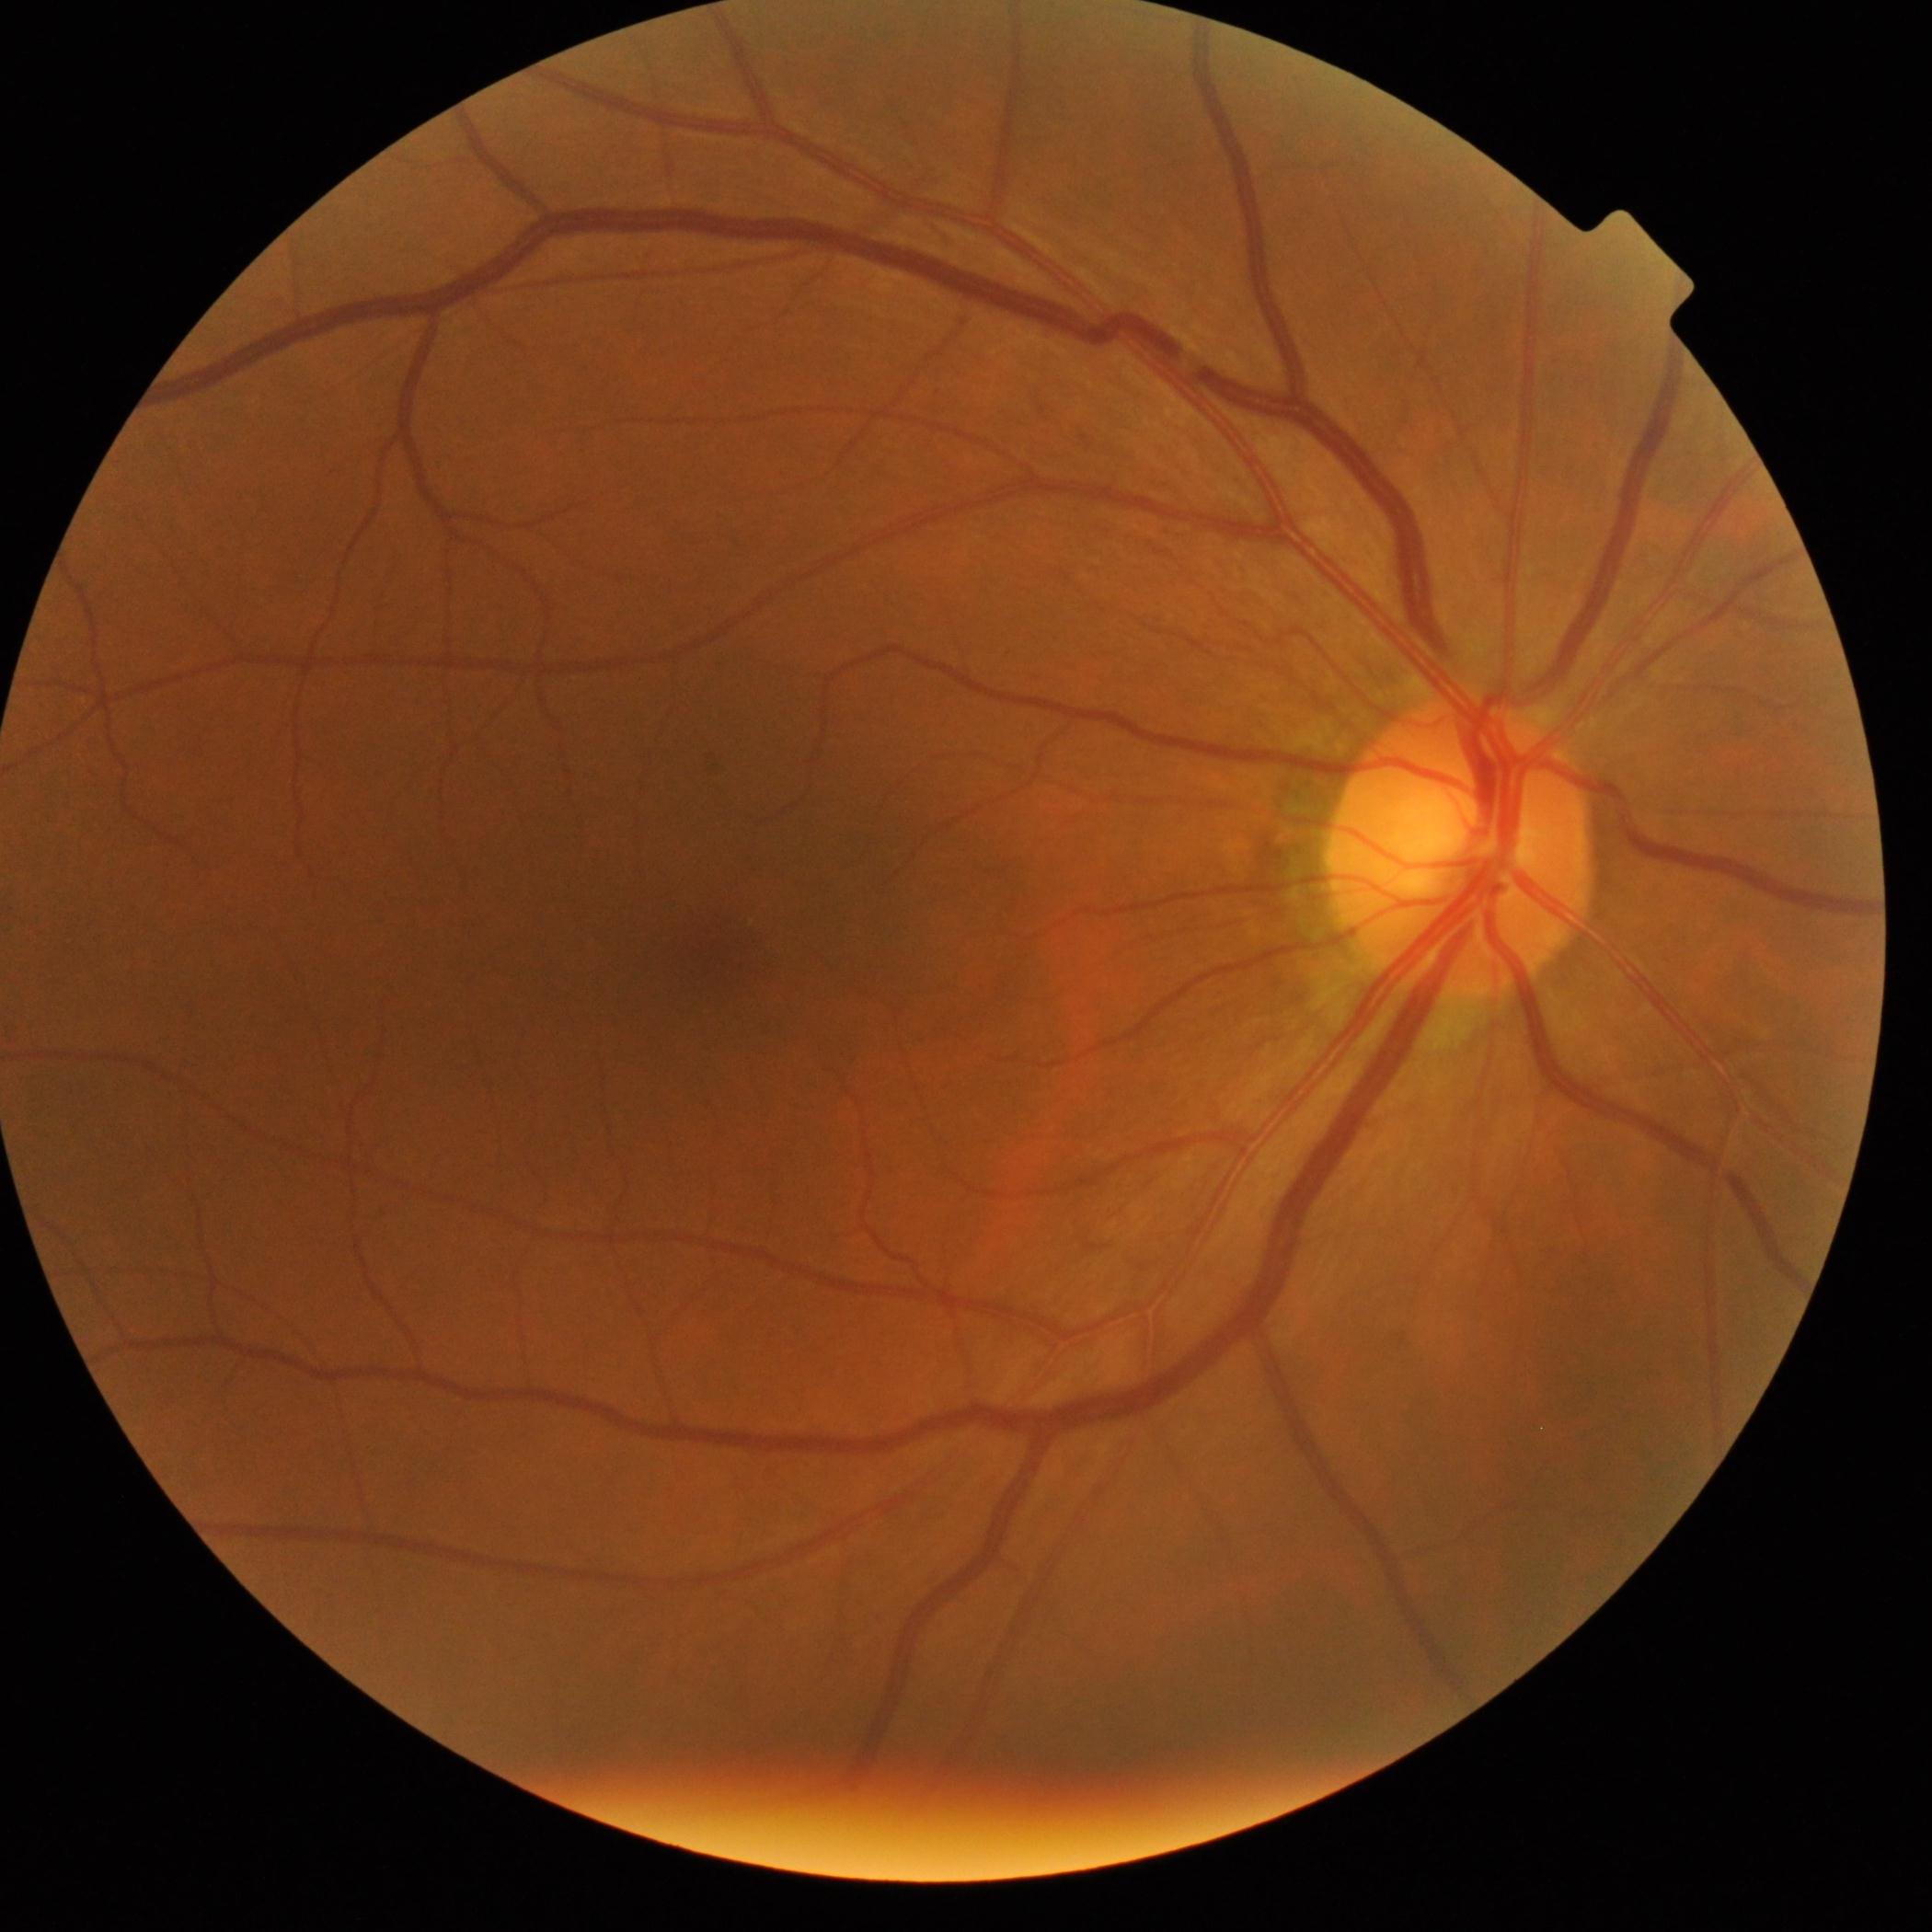 DR severity is 0.